Disc-centered fundus crop — 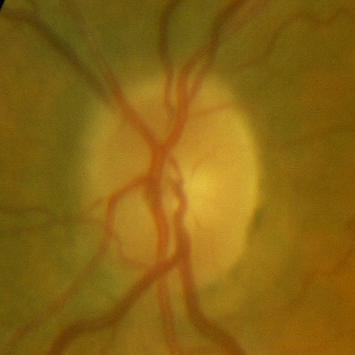

Glaucoma status = no glaucoma.